No pharmacologic dilation; color fundus image:
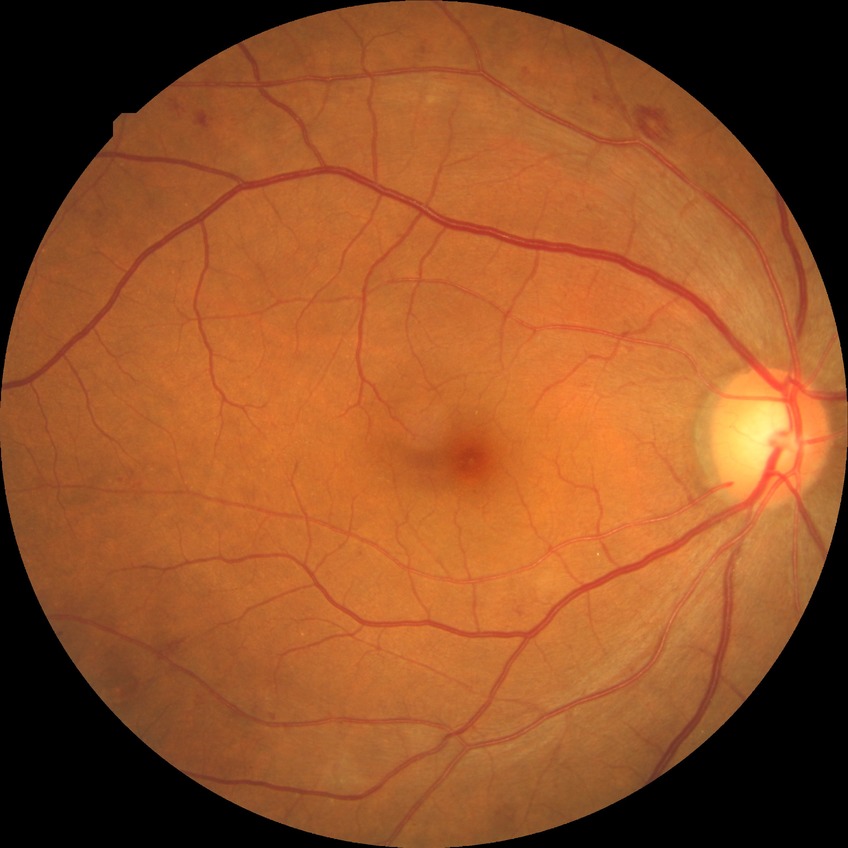

Diabetic retinopathy (DR): simple diabetic retinopathy (SDR).